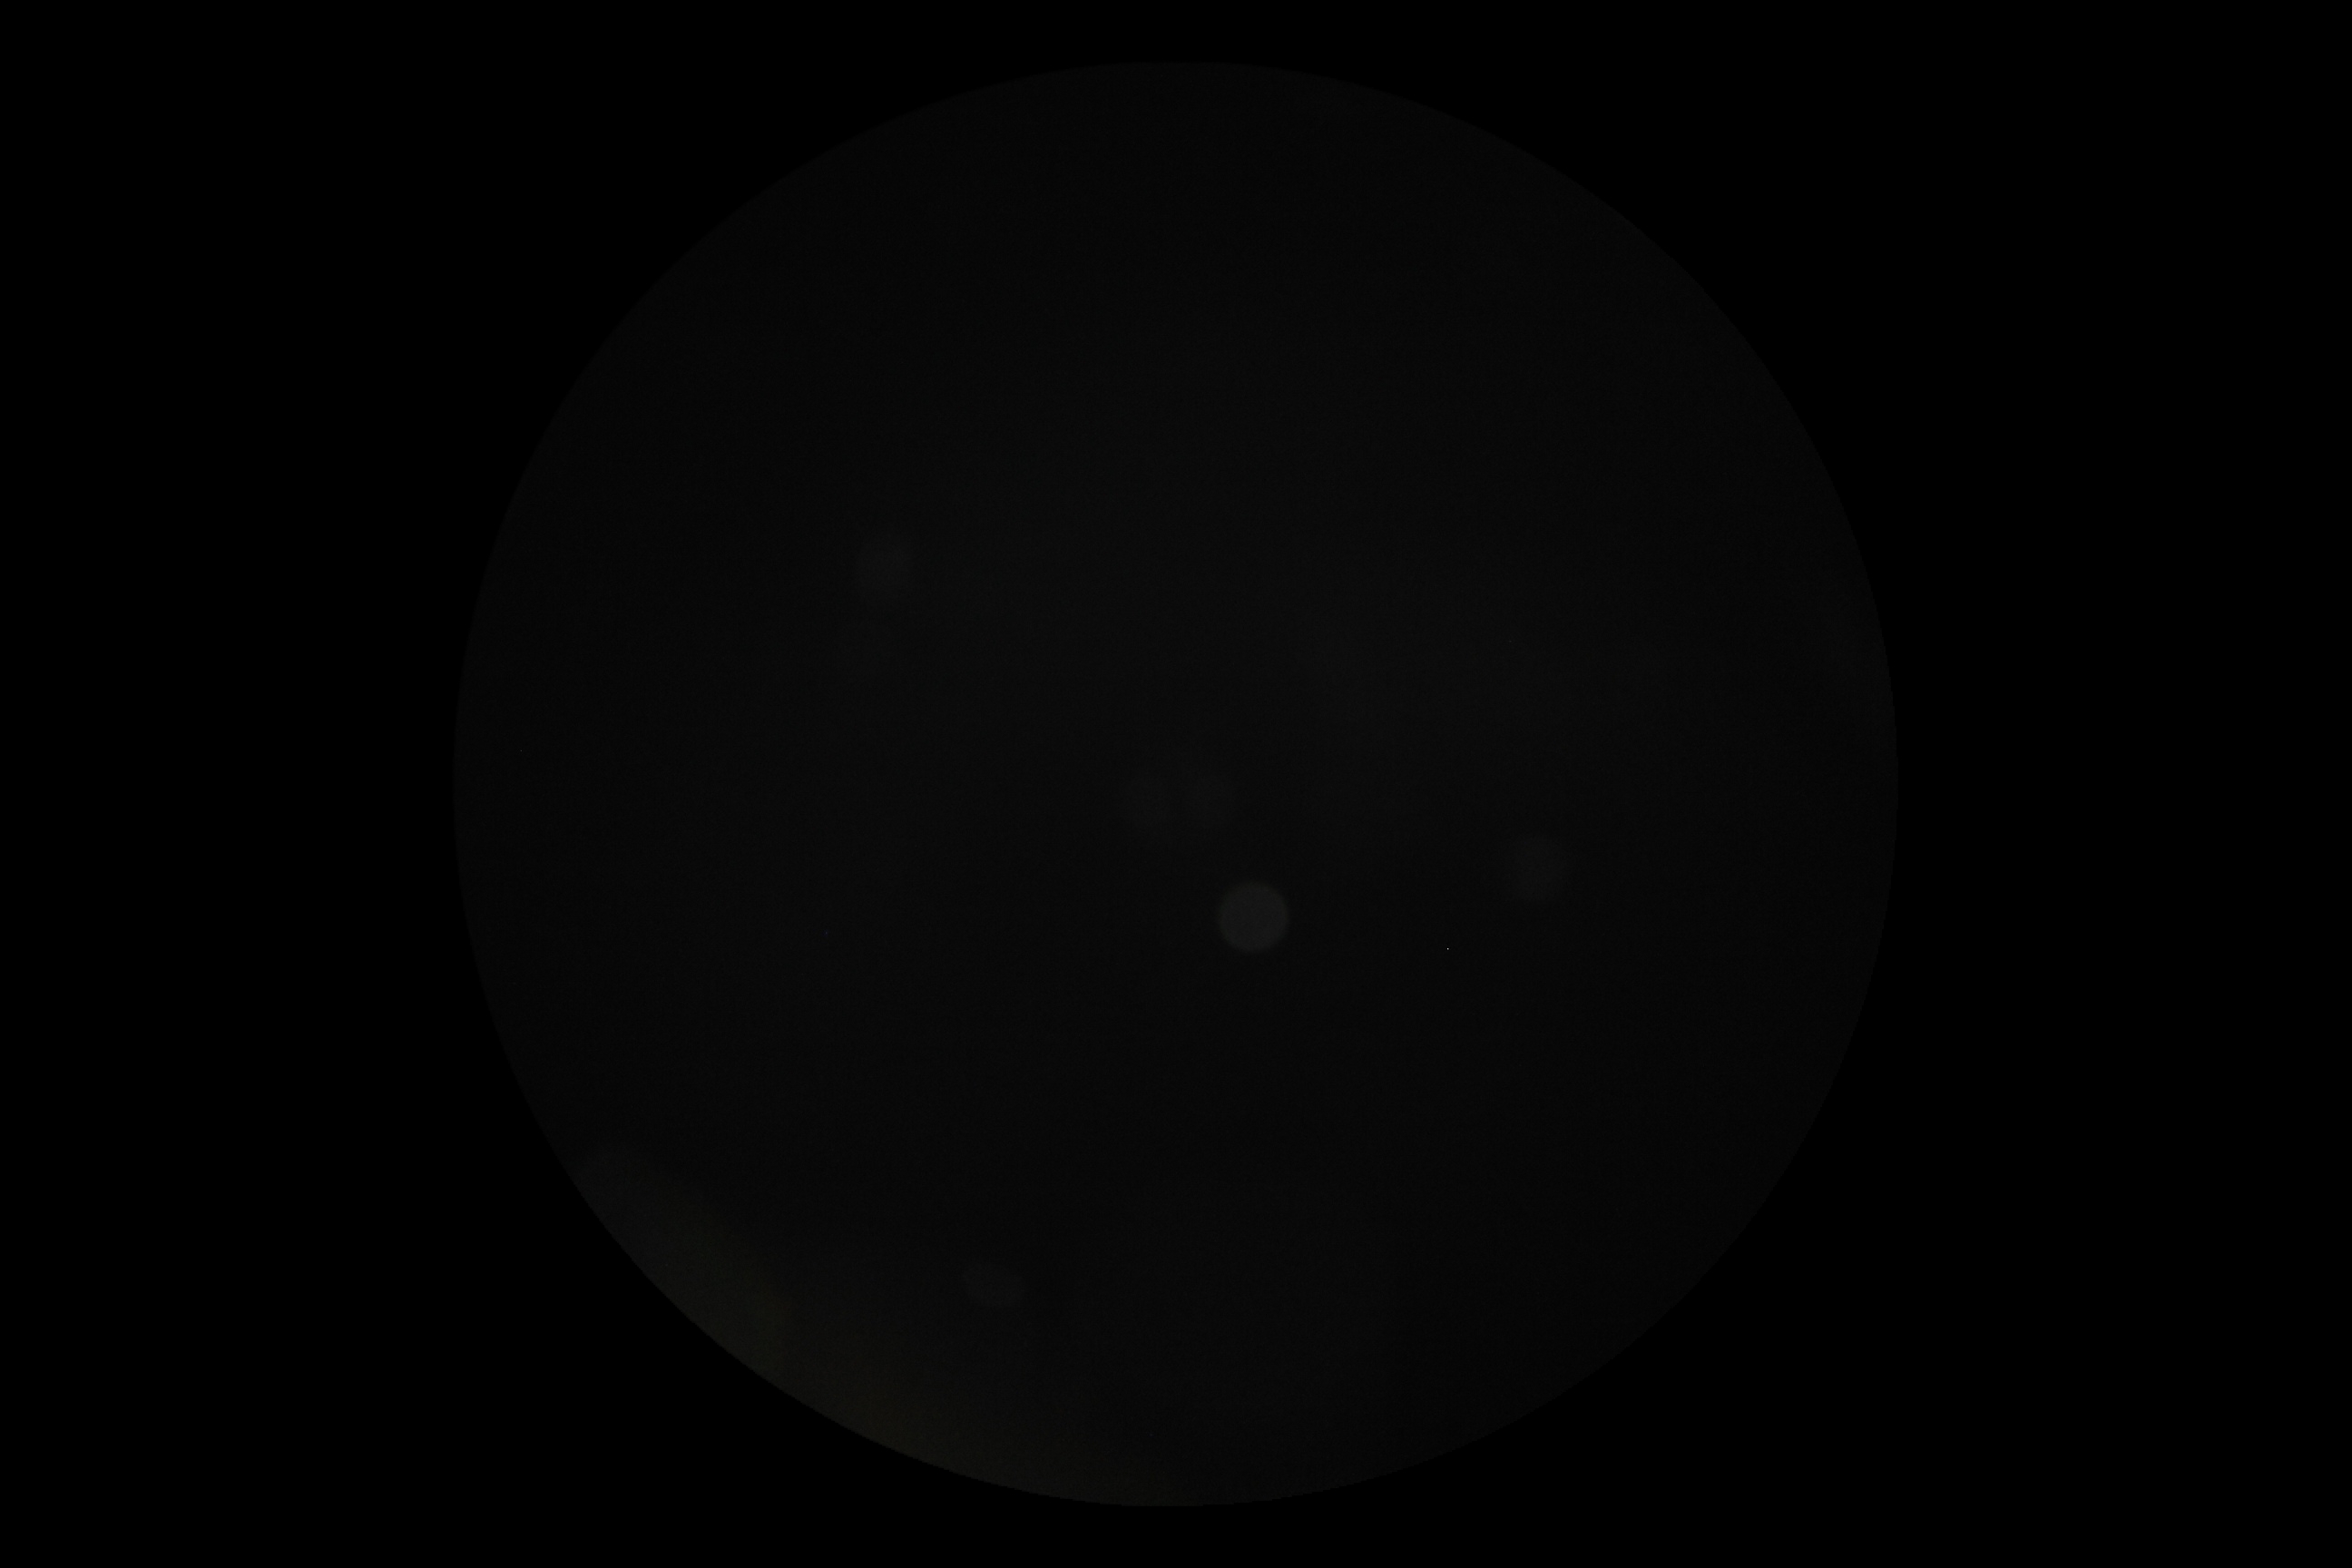

Quality too poor to assess for DR.
Diabetic retinopathy is ungradable due to poor image quality.